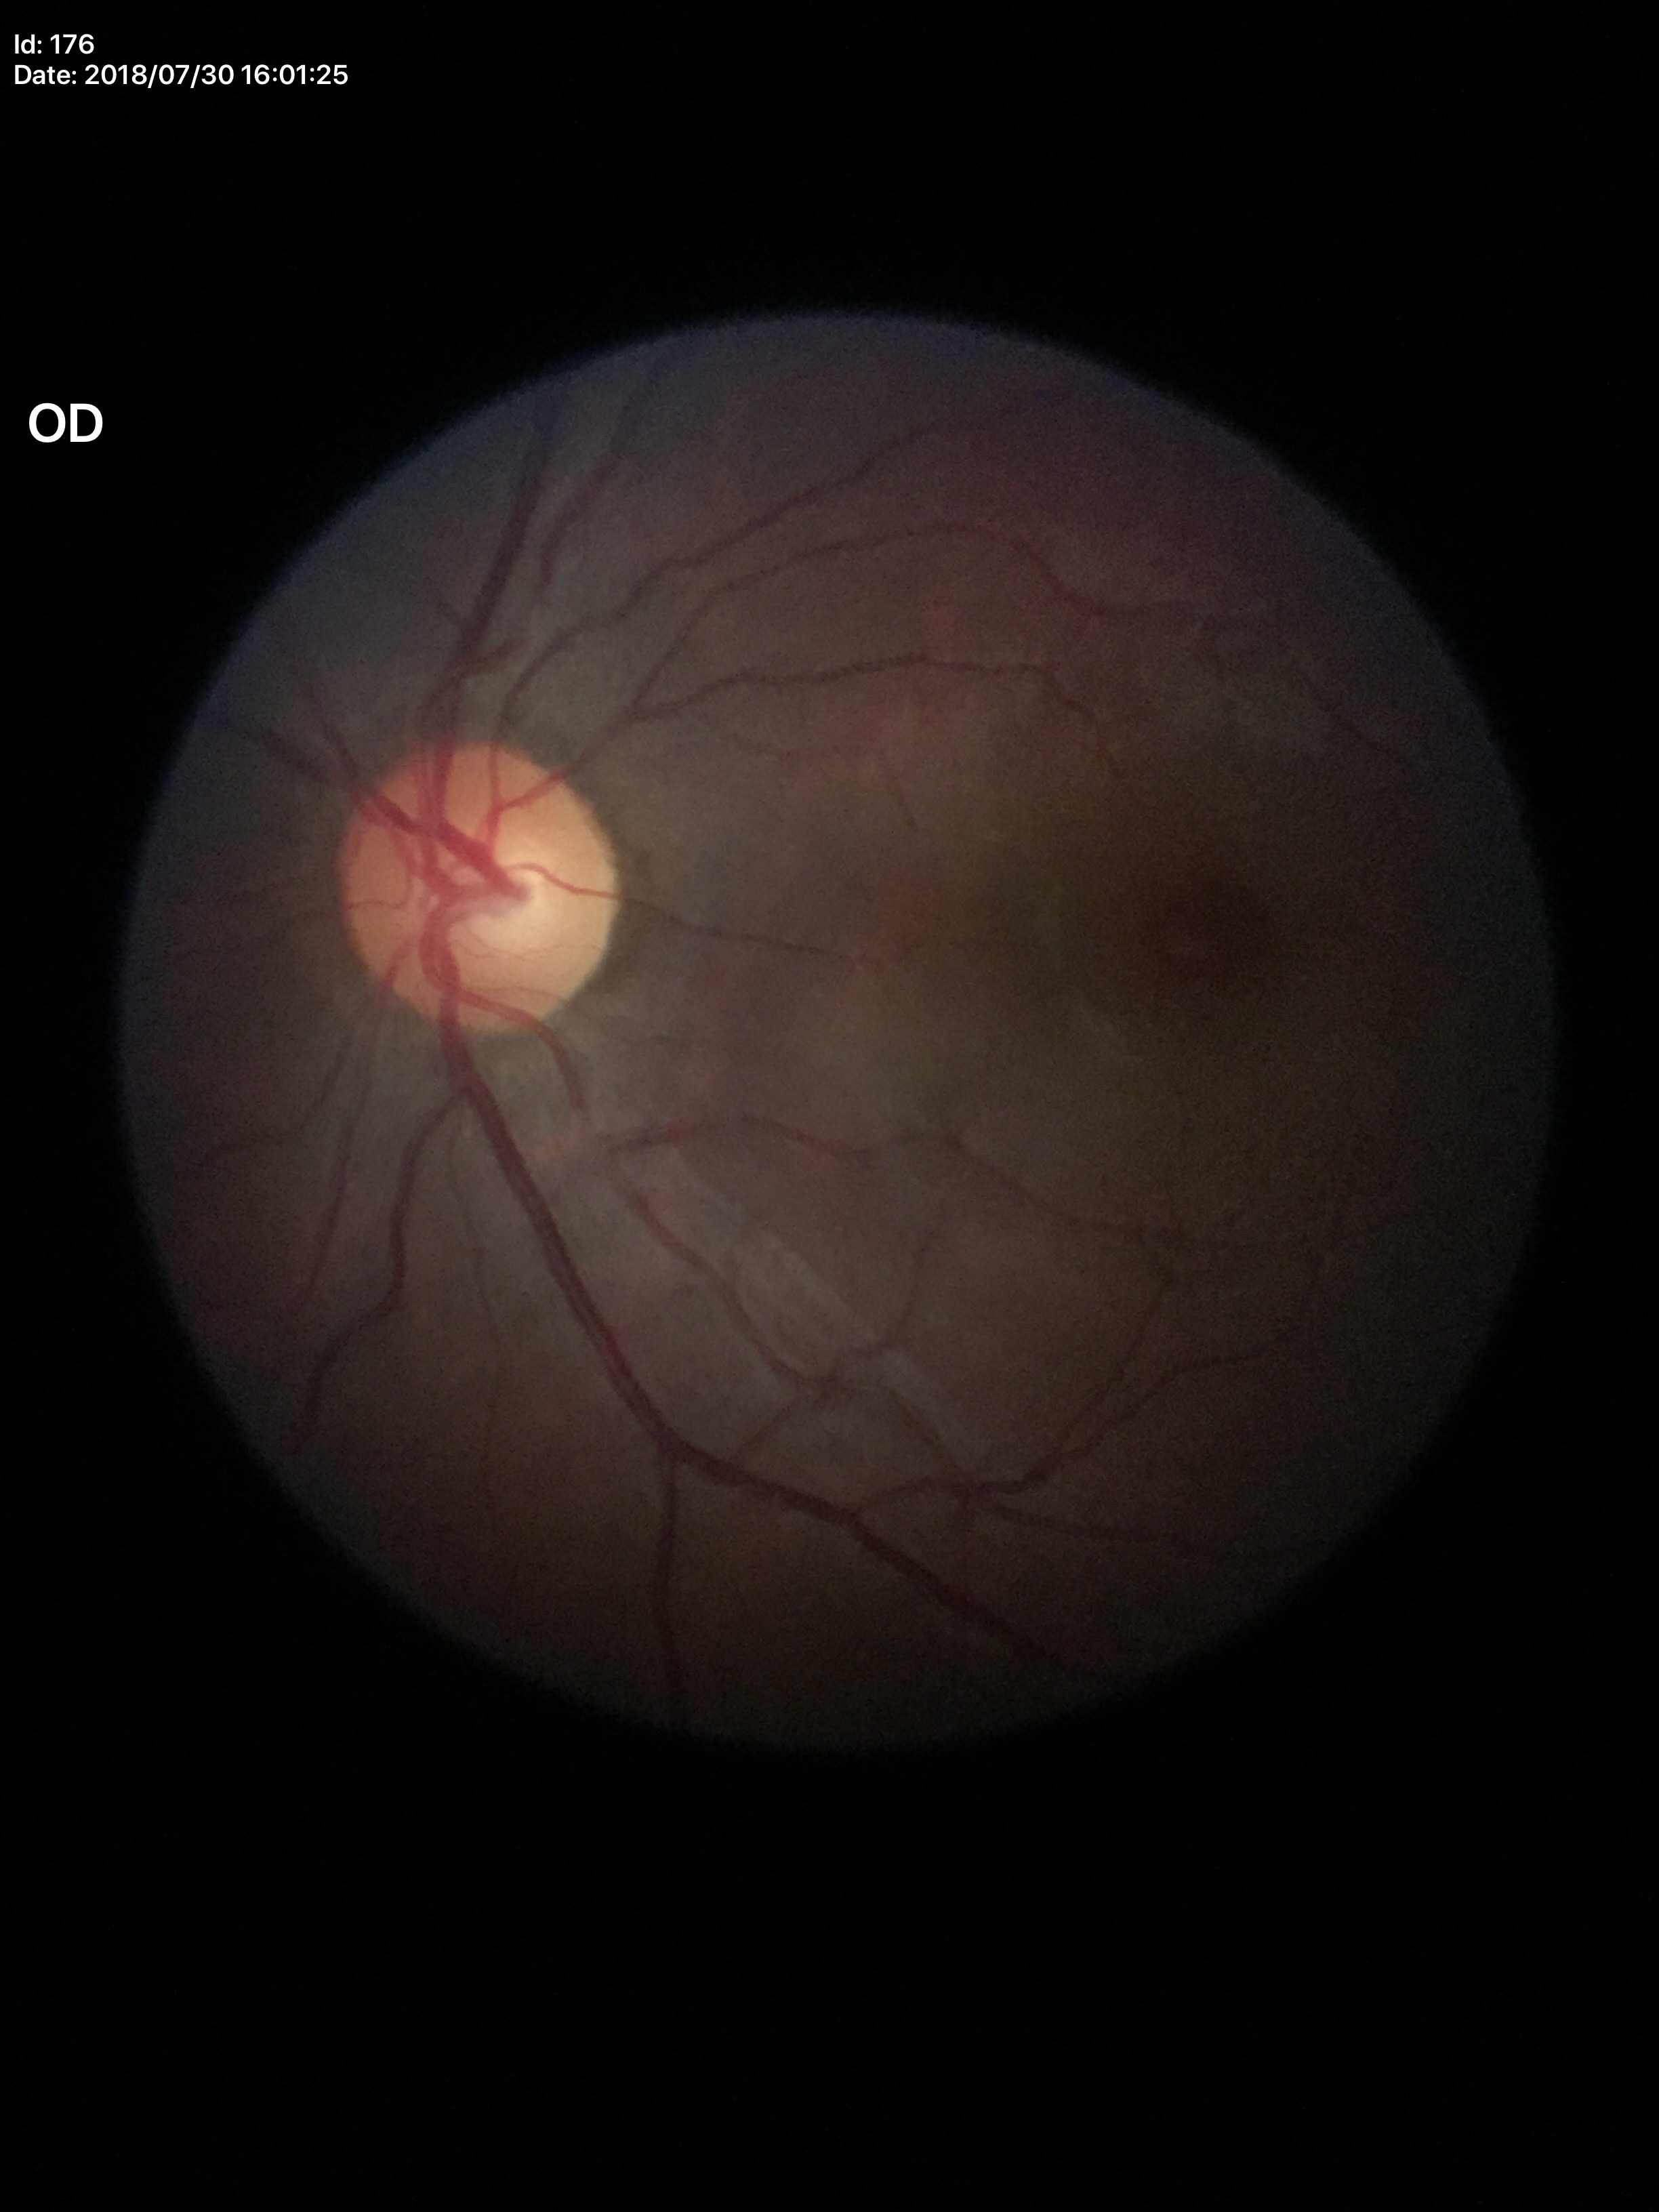

Glaucoma screening impression: not suspect. Vertical cup-disc ratio is 0.53. Horizontal C/D ratio: 0.56.